1932x1932.
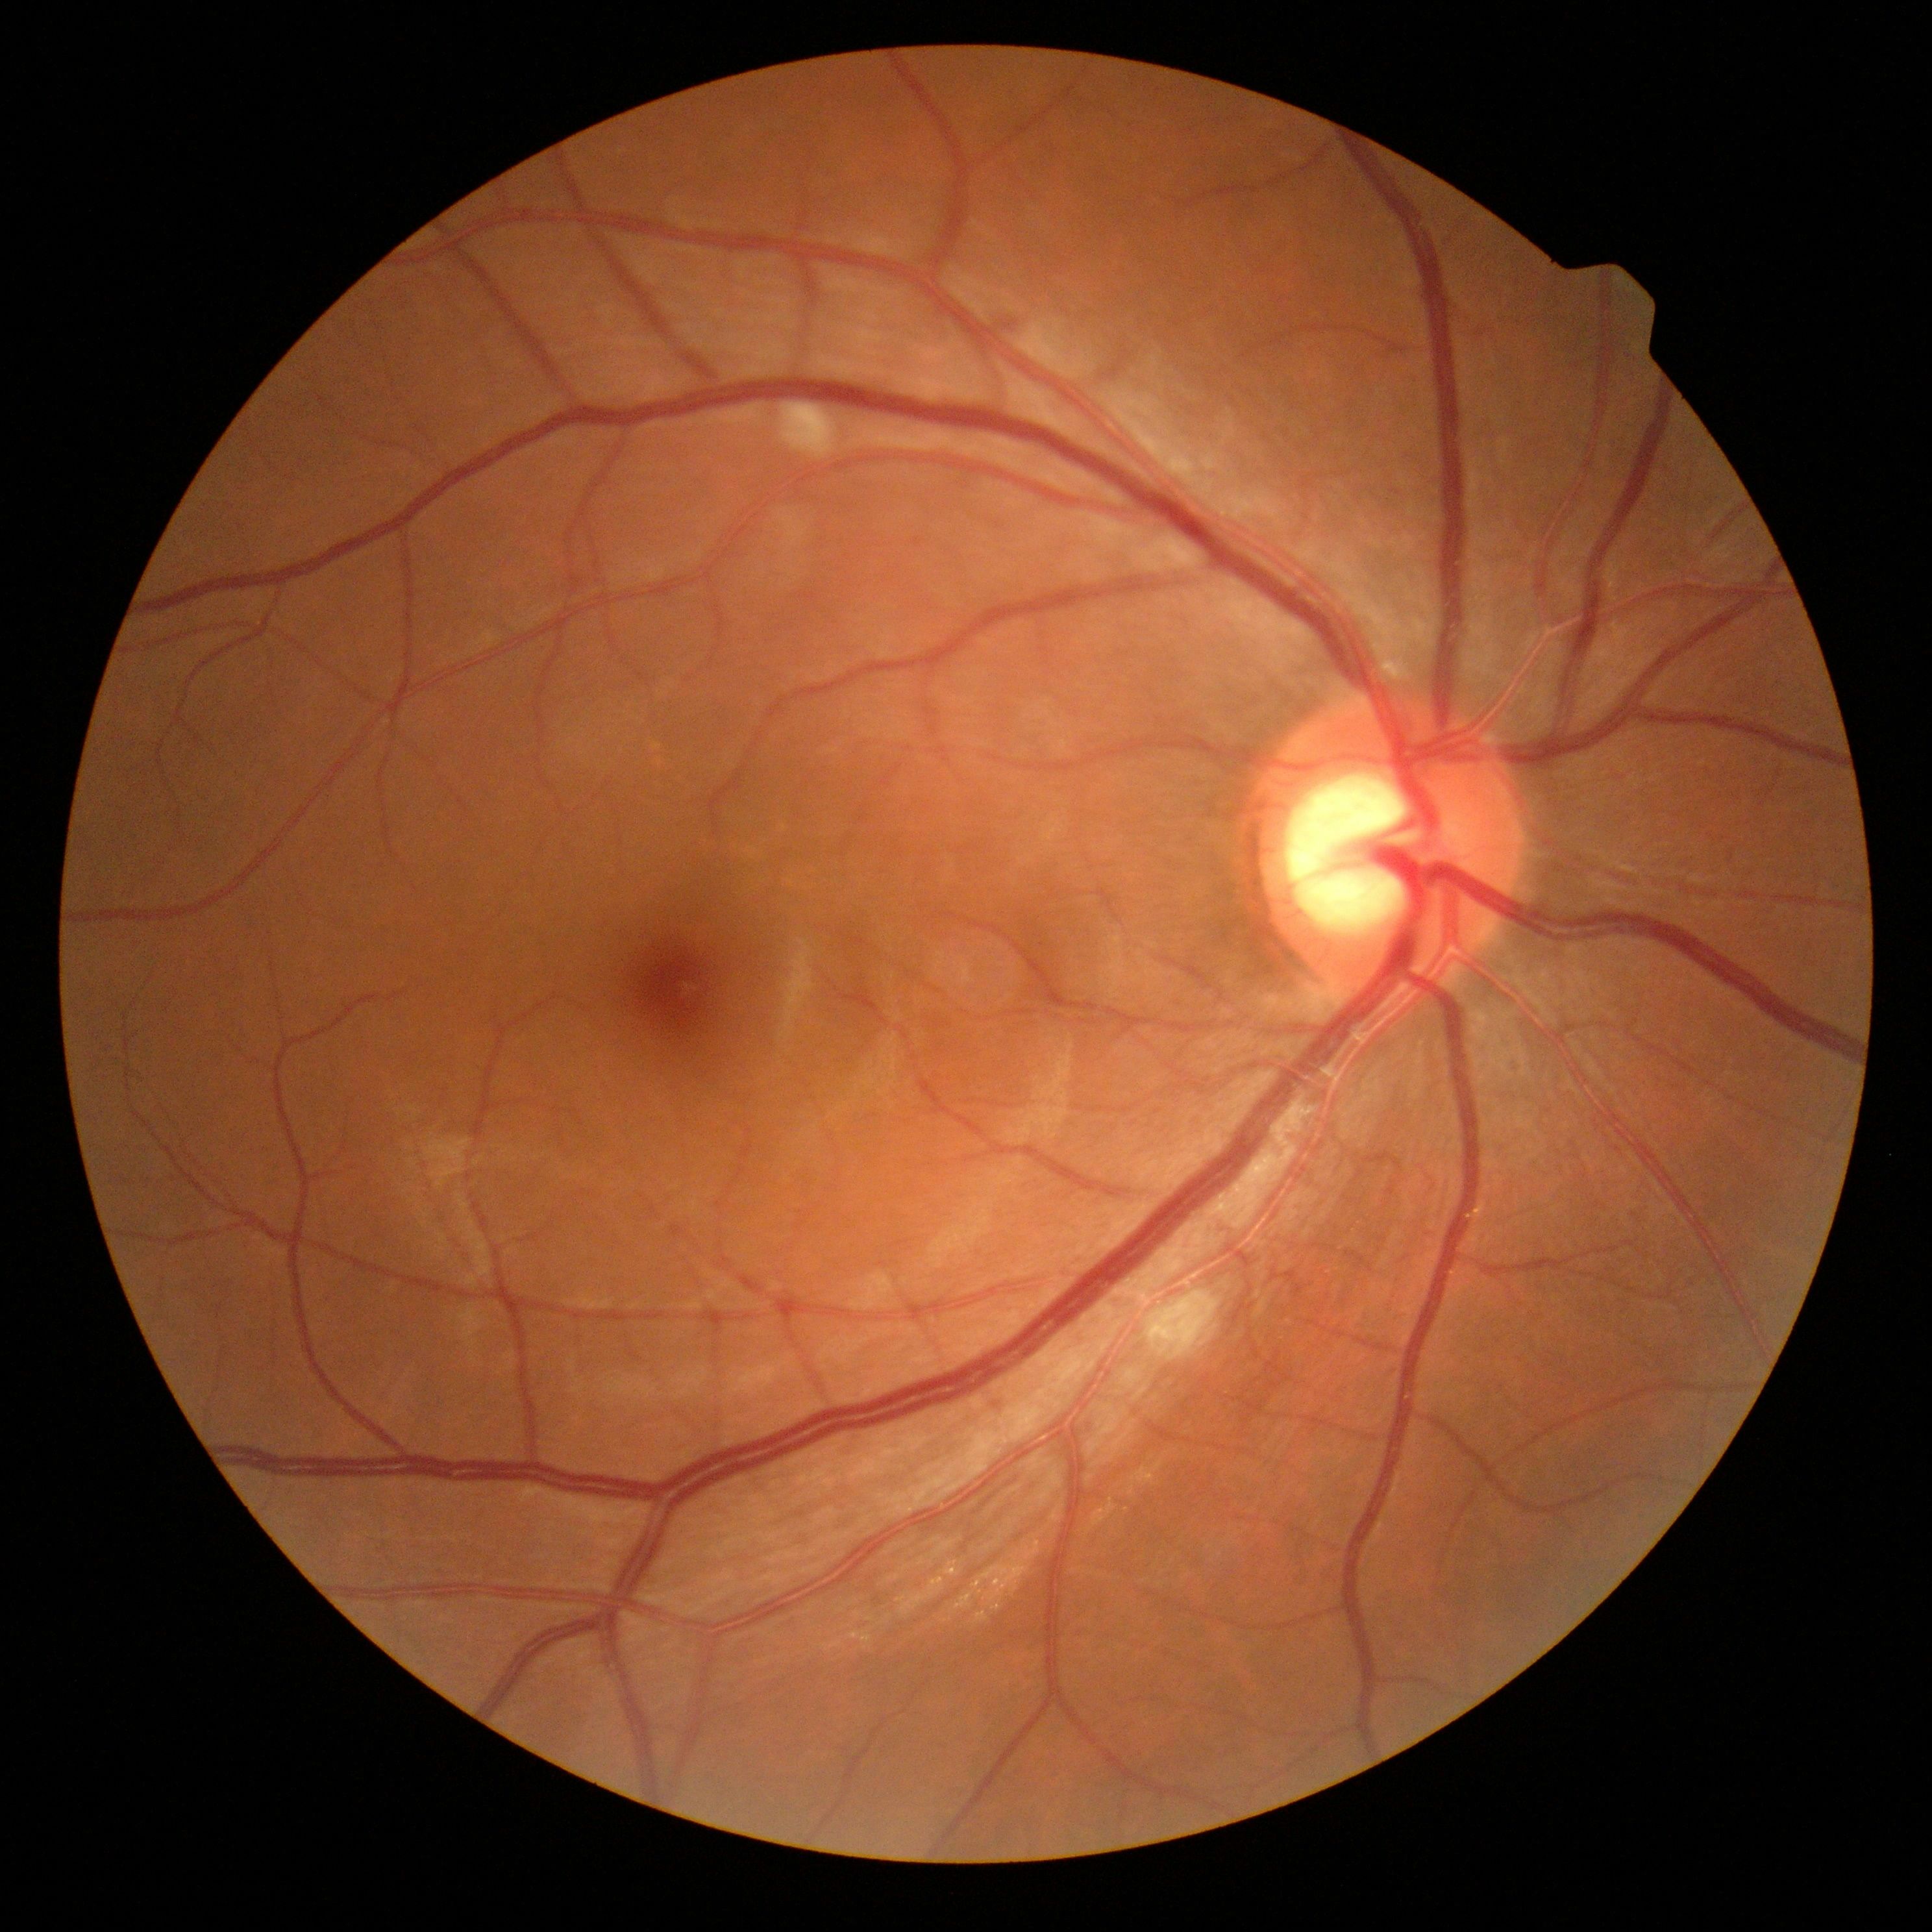
The retinopathy is classified as non-proliferative diabetic retinopathy. Diabetic retinopathy grade: 2 (moderate NPDR).